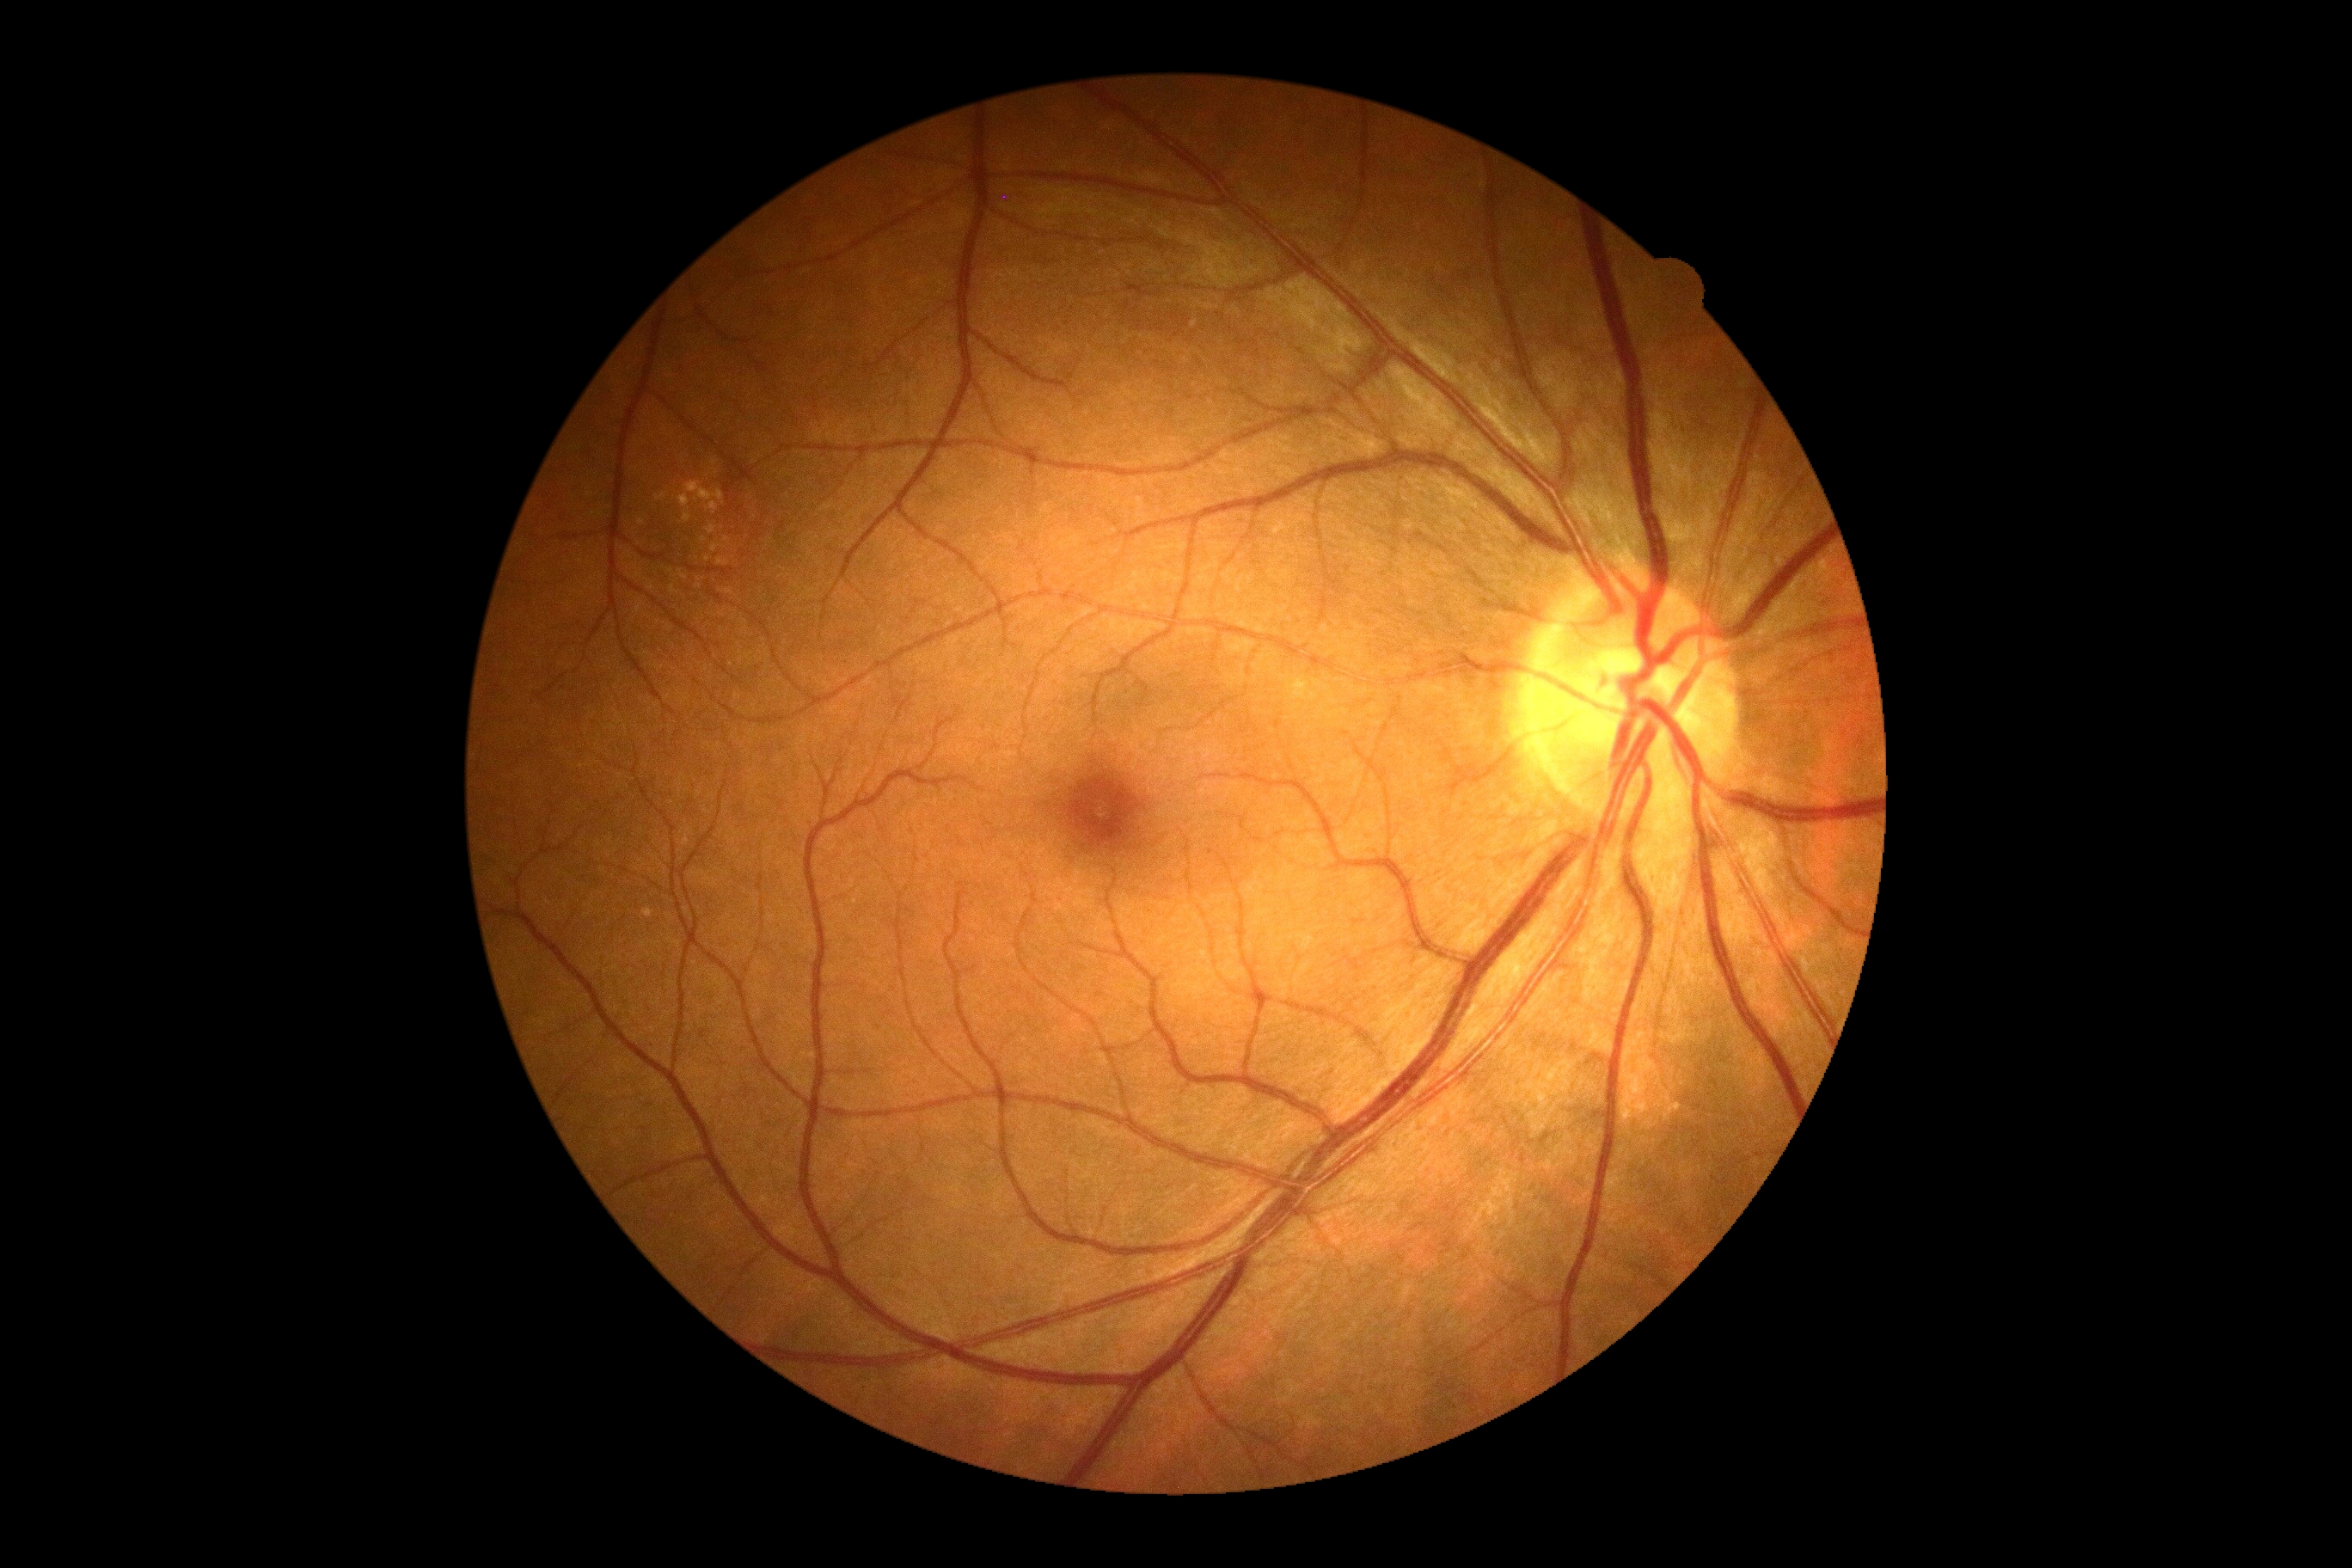
DR severity: 0/4 — no visible signs of diabetic retinopathy. No diabetic retinal disease findings.